240 x 240 pixels:
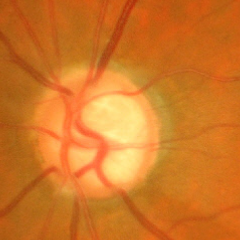

The image shows advanced glaucoma.